Nonmydriatic · 848 x 848 pixels · retinal fundus photograph · camera: NIDEK AFC-230 · 45 degree fundus photograph
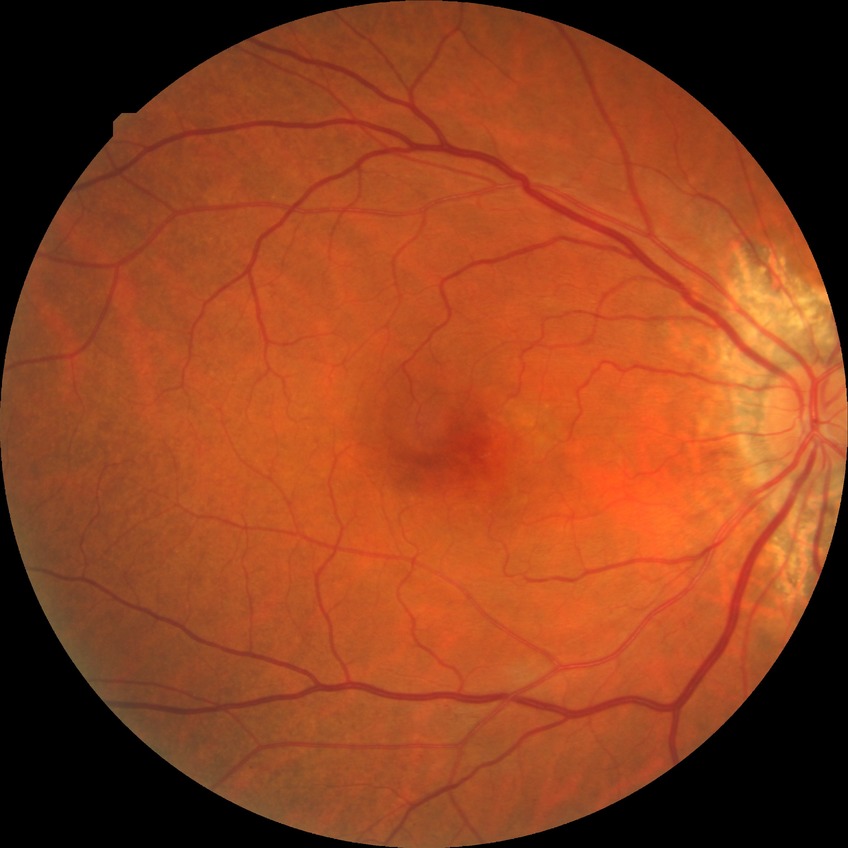 - DR: NDR
- DR impression: no apparent DR